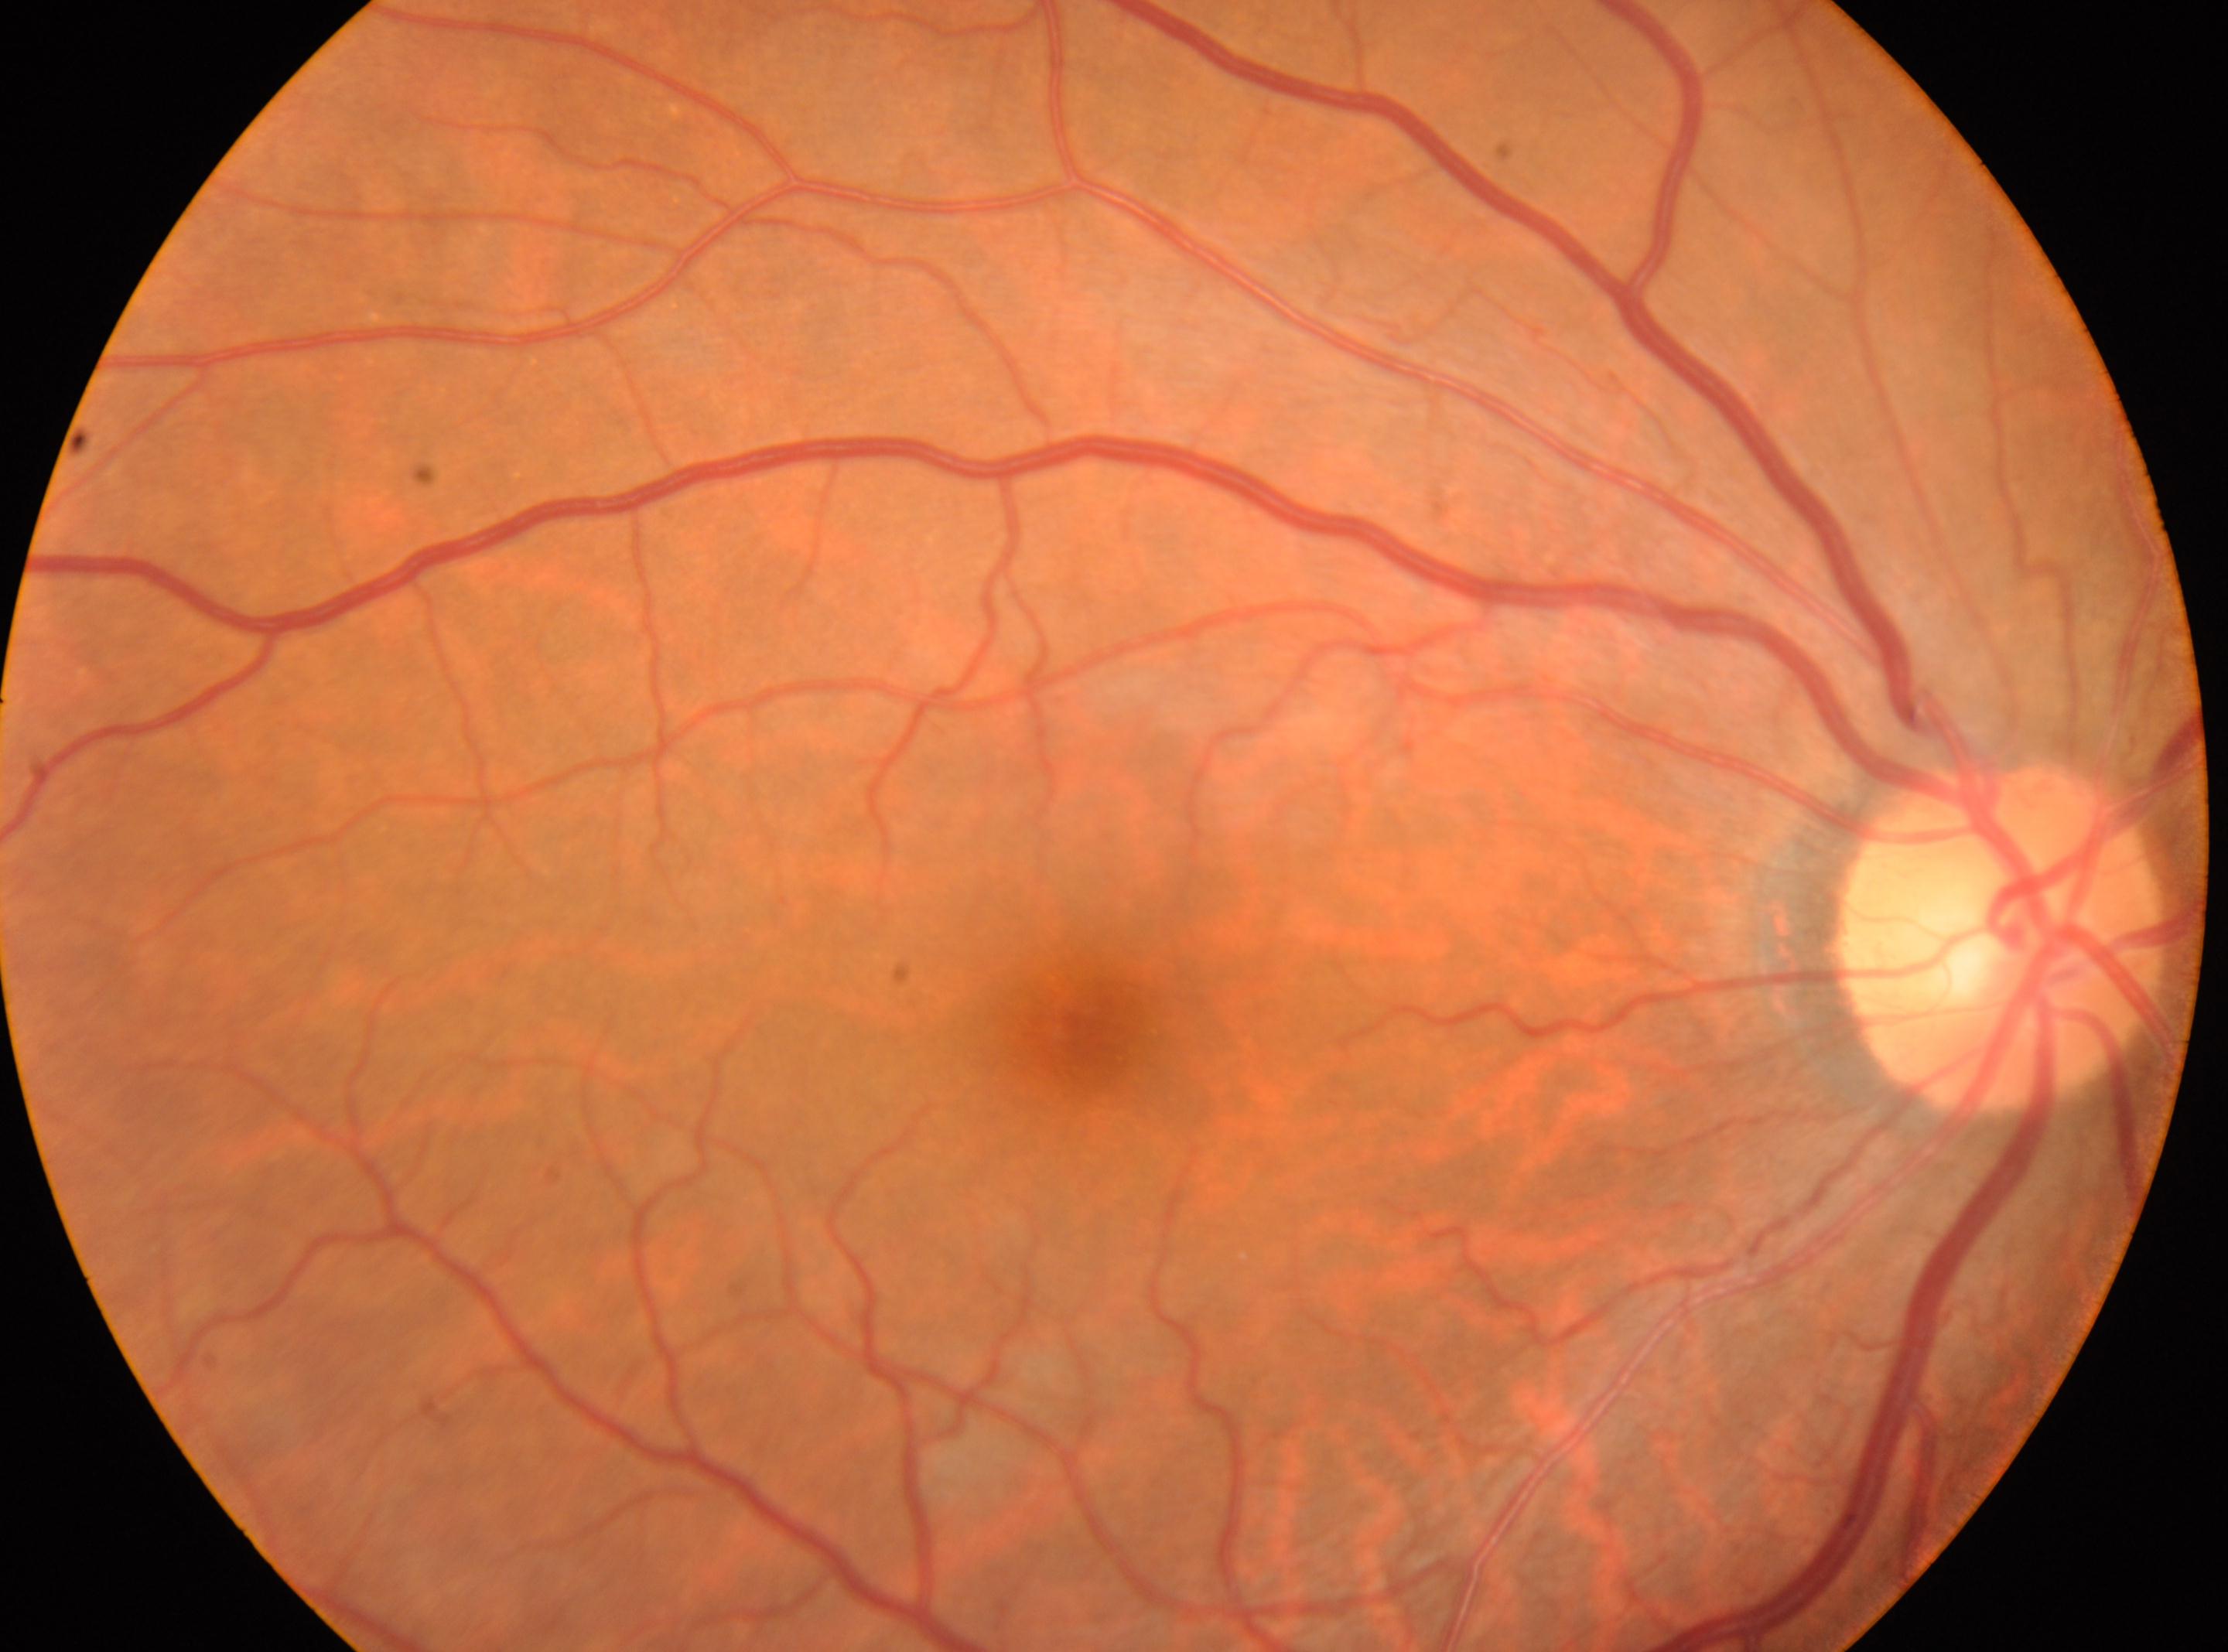

No diabetic retinal disease findings.
DR severity is grade 0 (no apparent retinopathy).
The optic nerve head is at x=2001, y=936.
Macular center: x=1095, y=1044.
Eye: oculus dexter.